Captured after pupil dilation · color fundus image · acquired with a Topcon TRC-50DX · FOV: 50 degrees · 2228x1652 · posterior pole view: 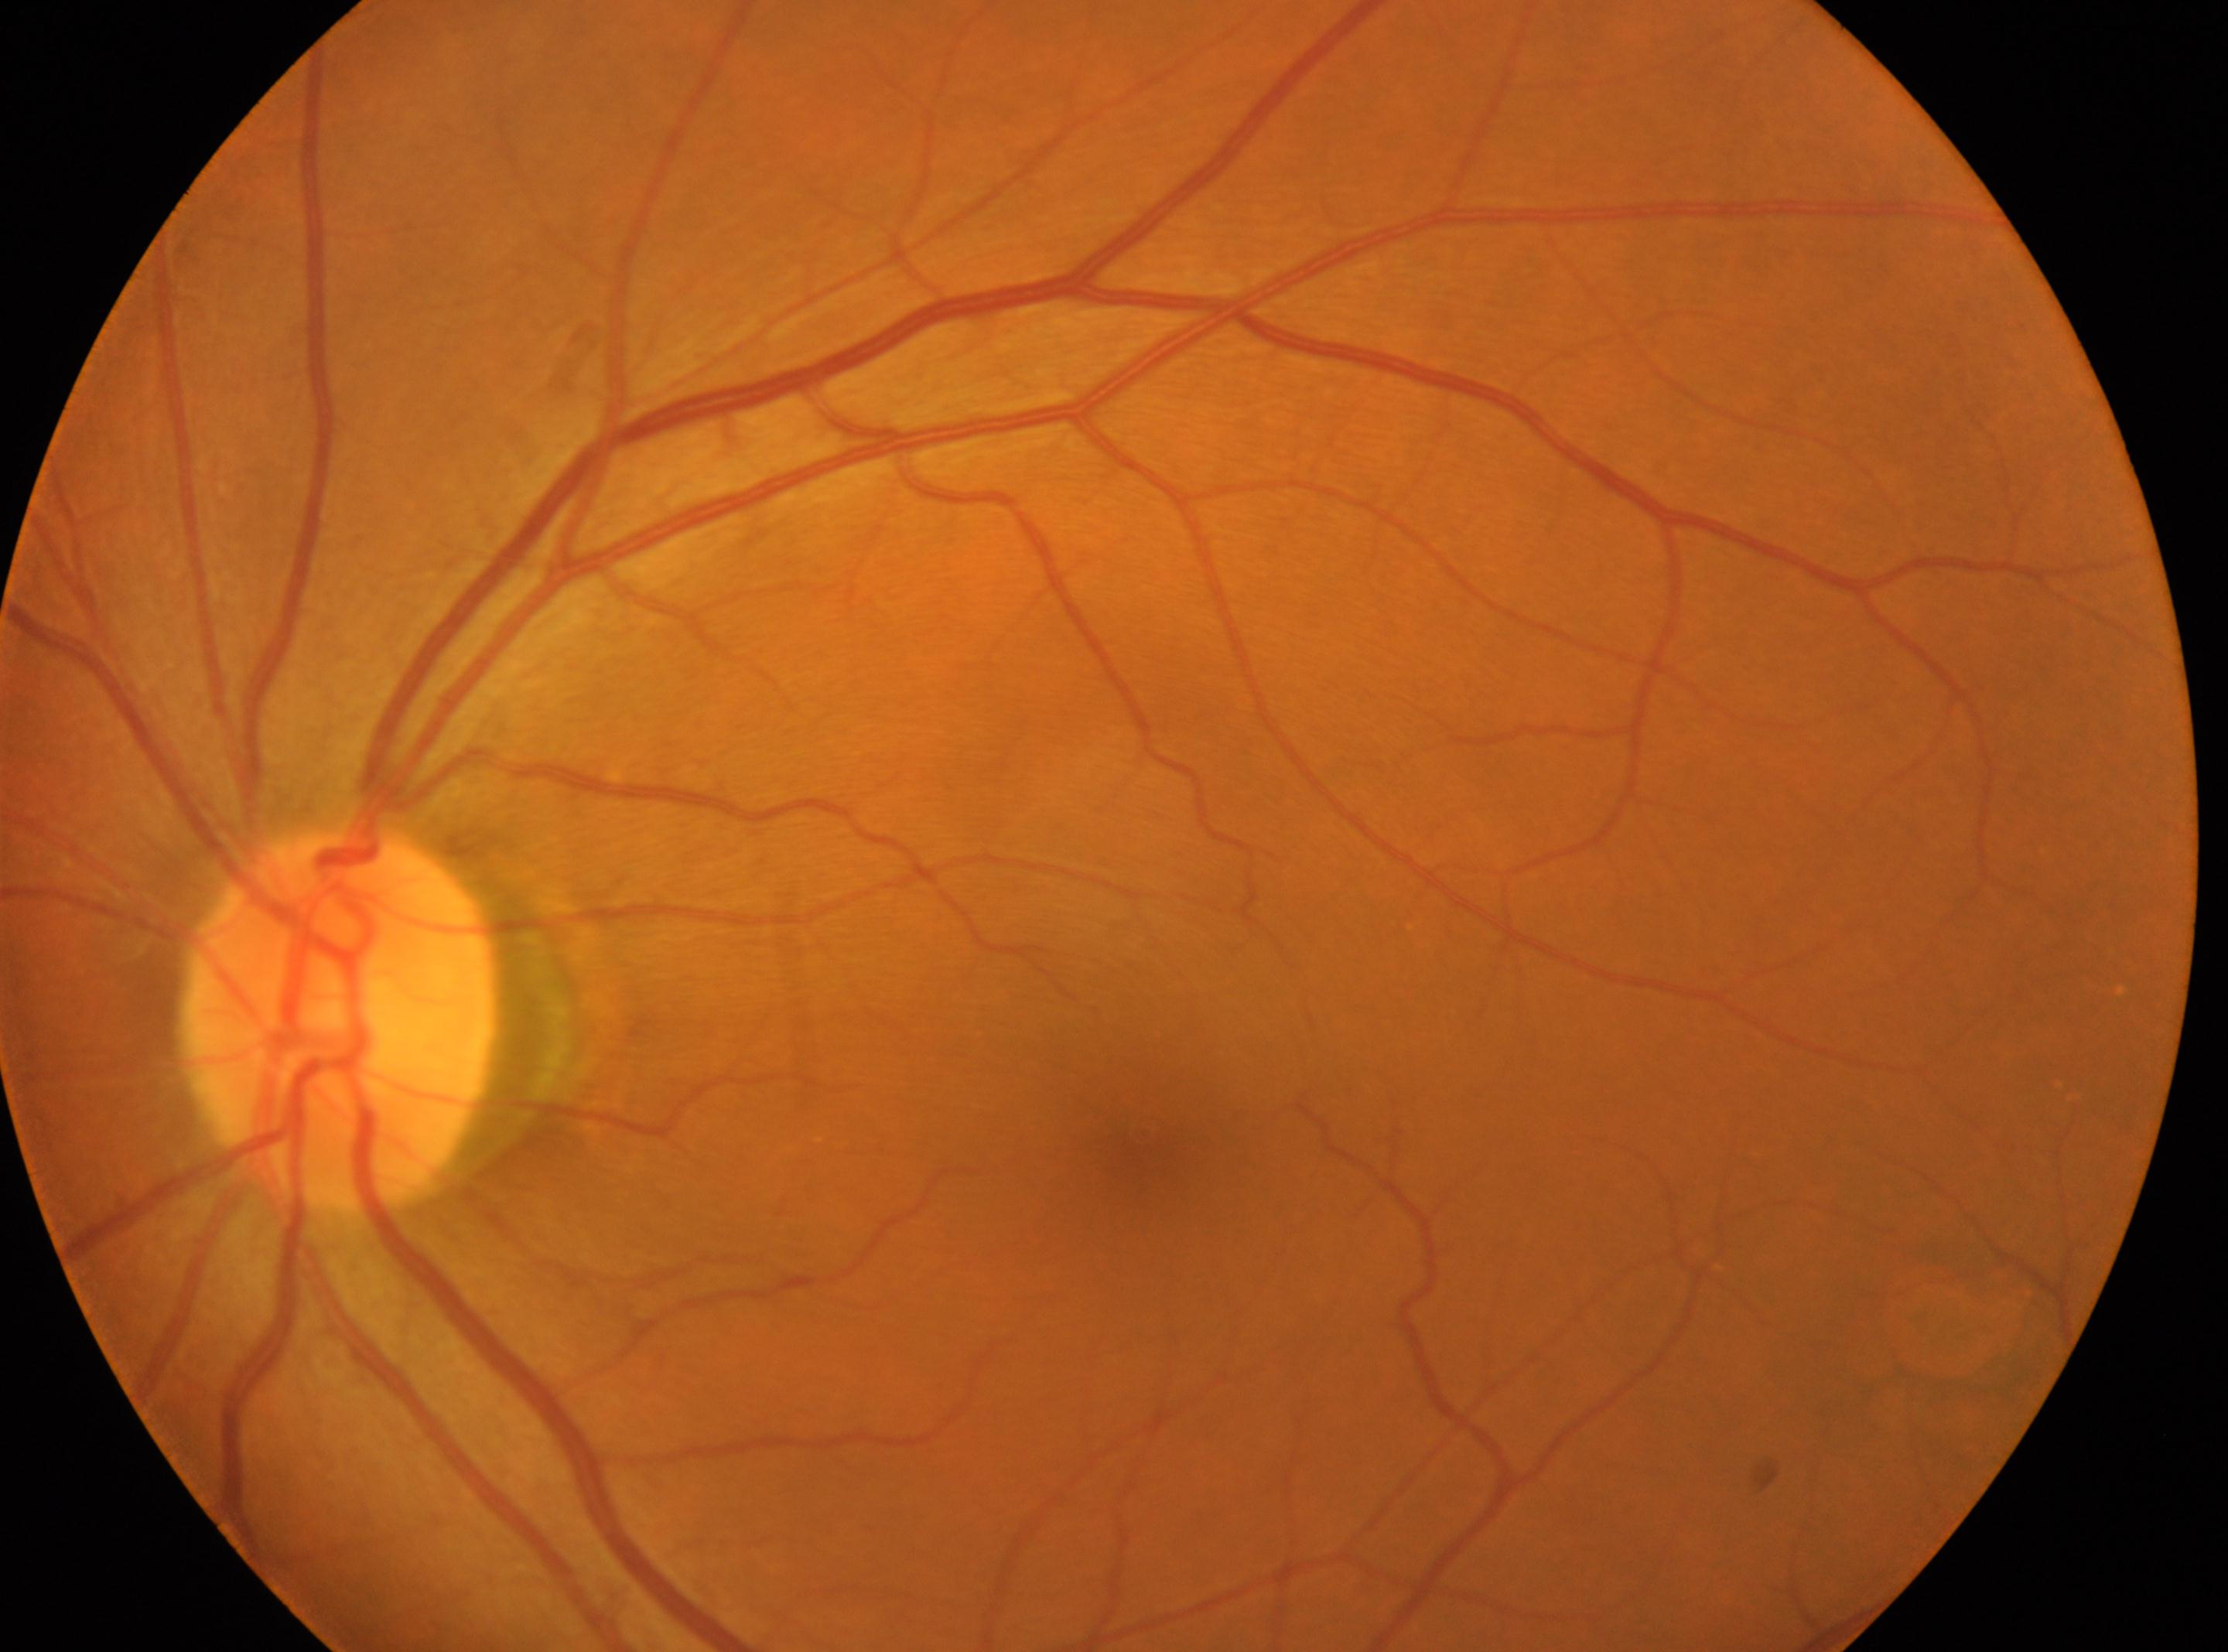 Q: Is there DR?
A: No diabetic retinopathy identified
Q: Right or left eye?
A: the left eye
Q: Where is the fovea?
A: x=1145, y=1132
Q: Diabetic retinopathy severity?
A: grade 0 (no apparent retinopathy)
Q: Where is the optic disc?
A: x=334, y=1022